Davis DR grading — 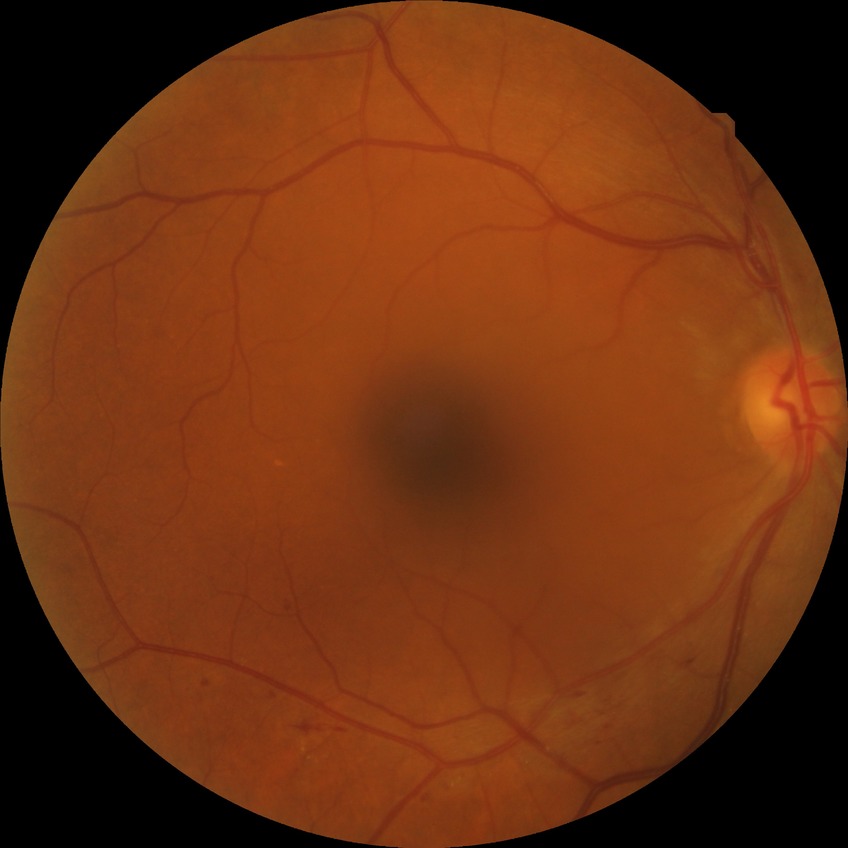
Diabetic retinopathy (DR): simple diabetic retinopathy (SDR).